45-degree field of view
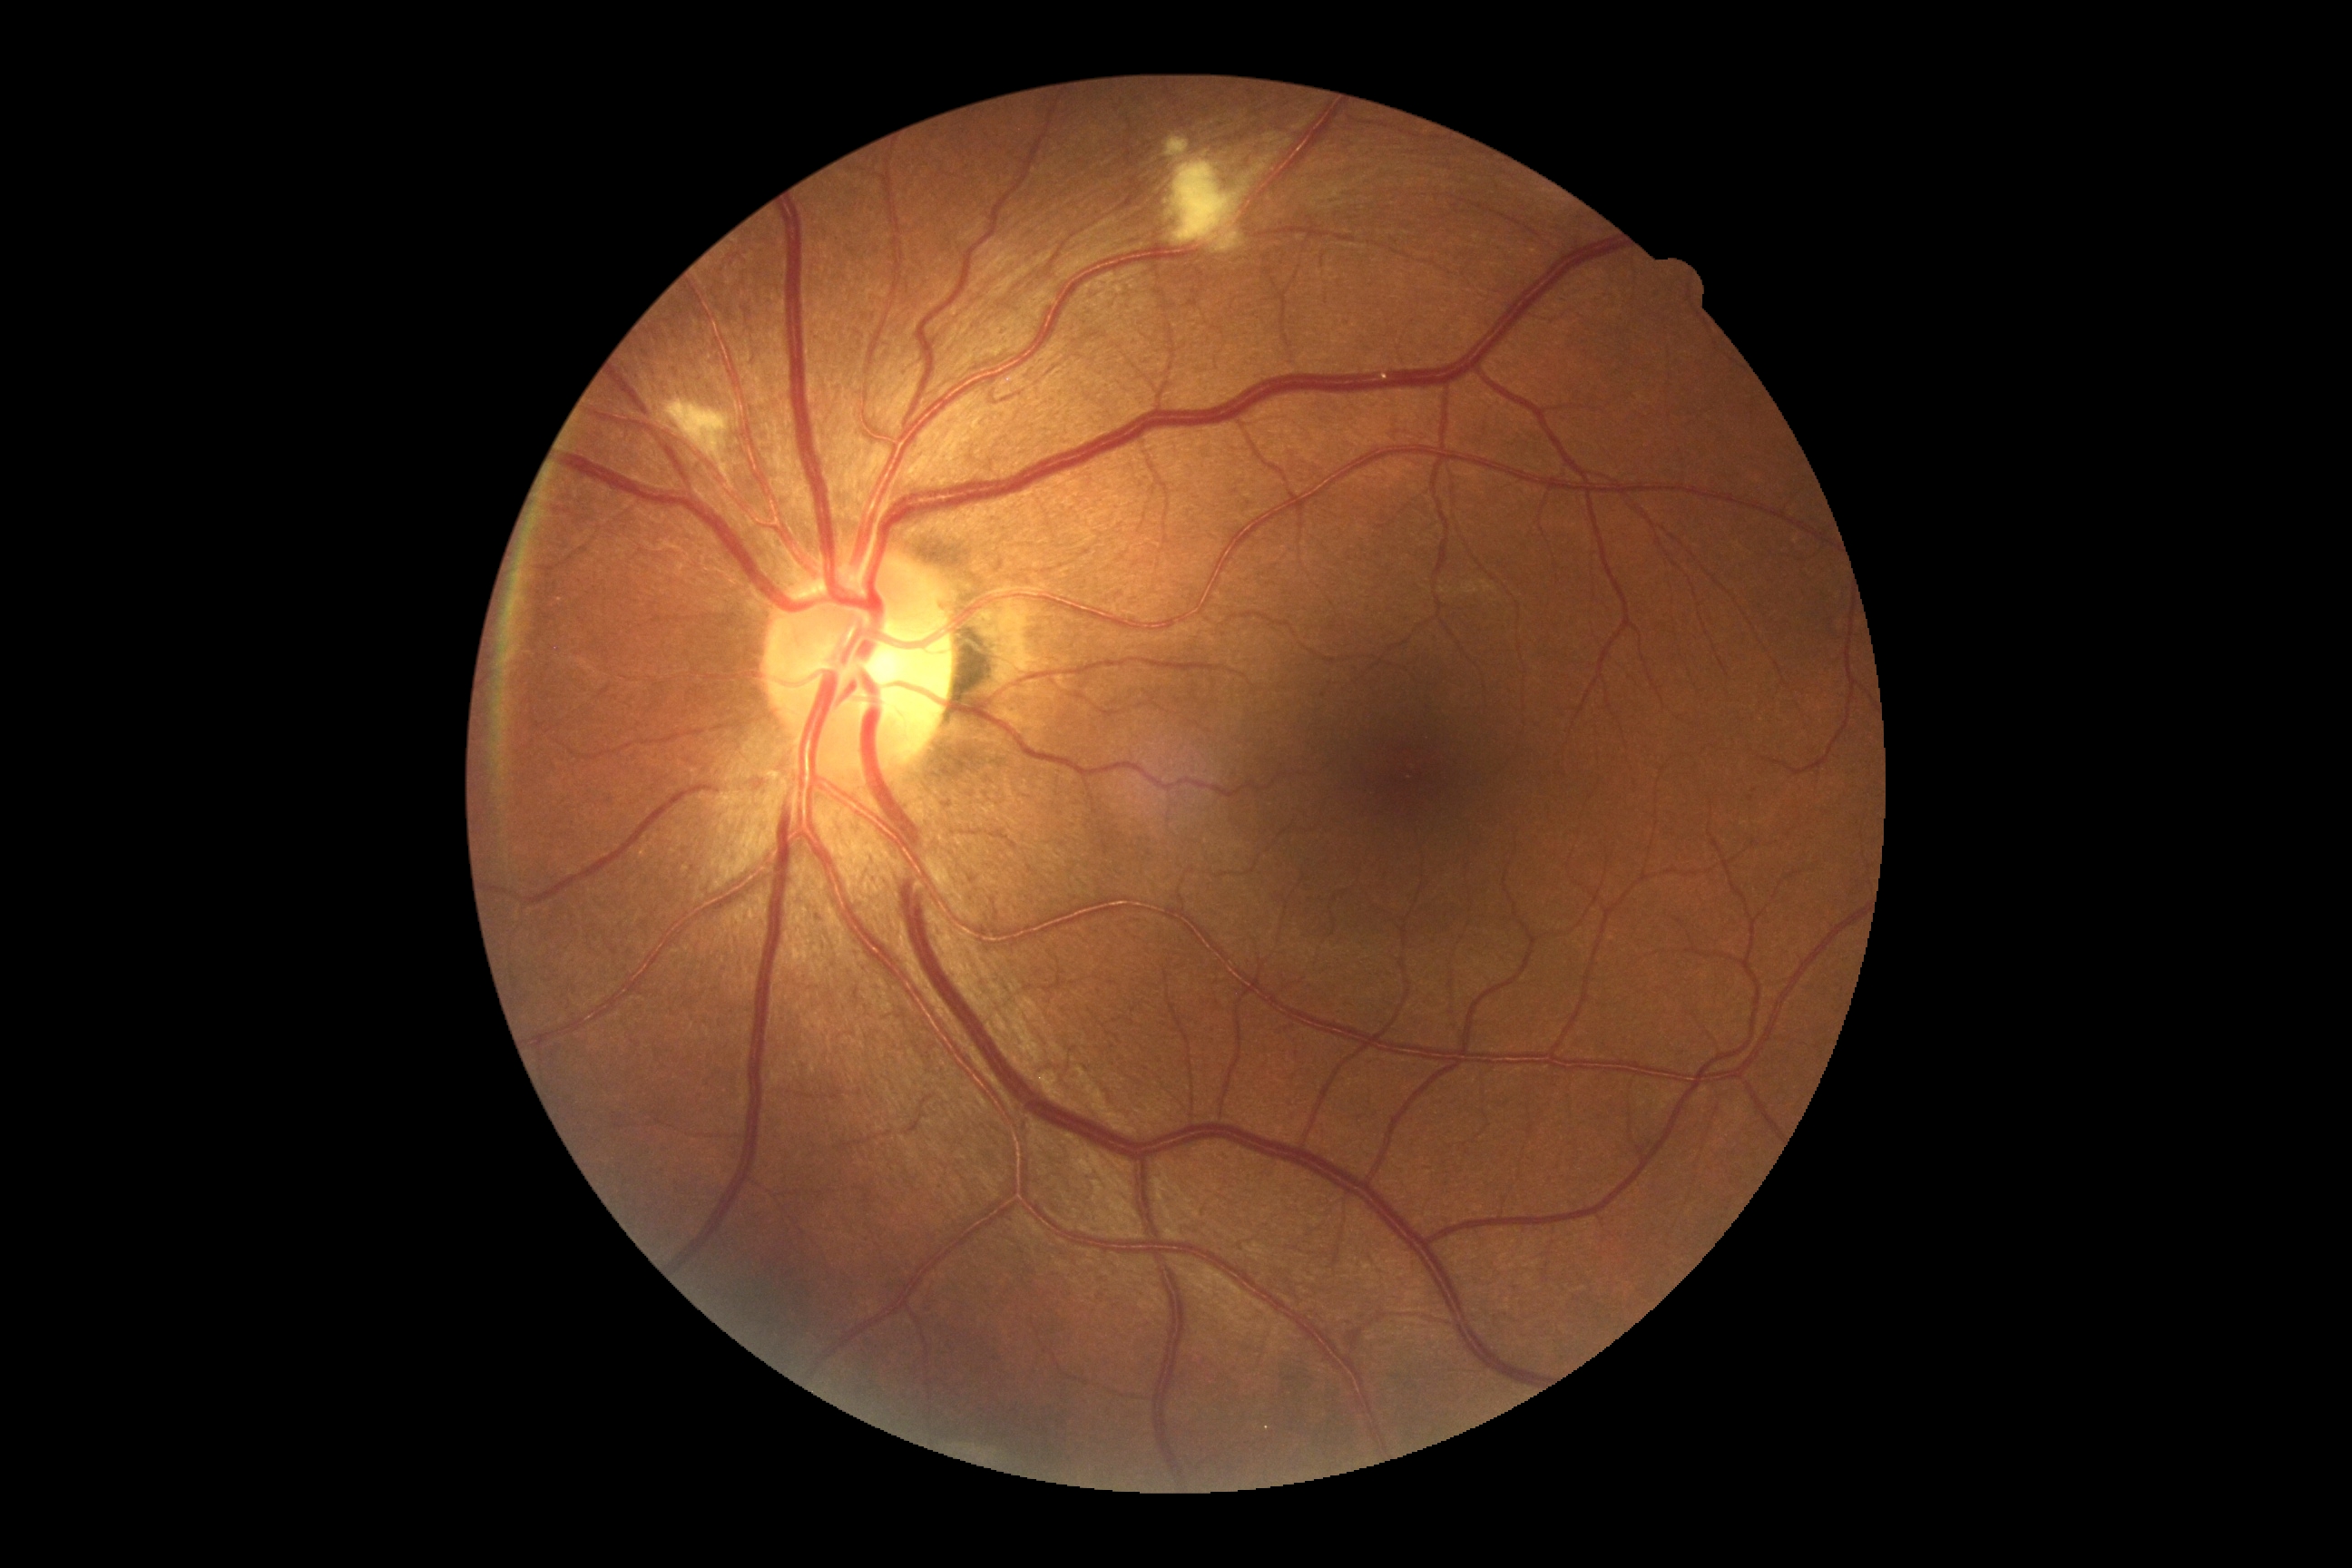
DR class=non-proliferative diabetic retinopathy, diabetic retinopathy (DR)=2.